NIDEK AFC-230. 45° FOV. 848x848: 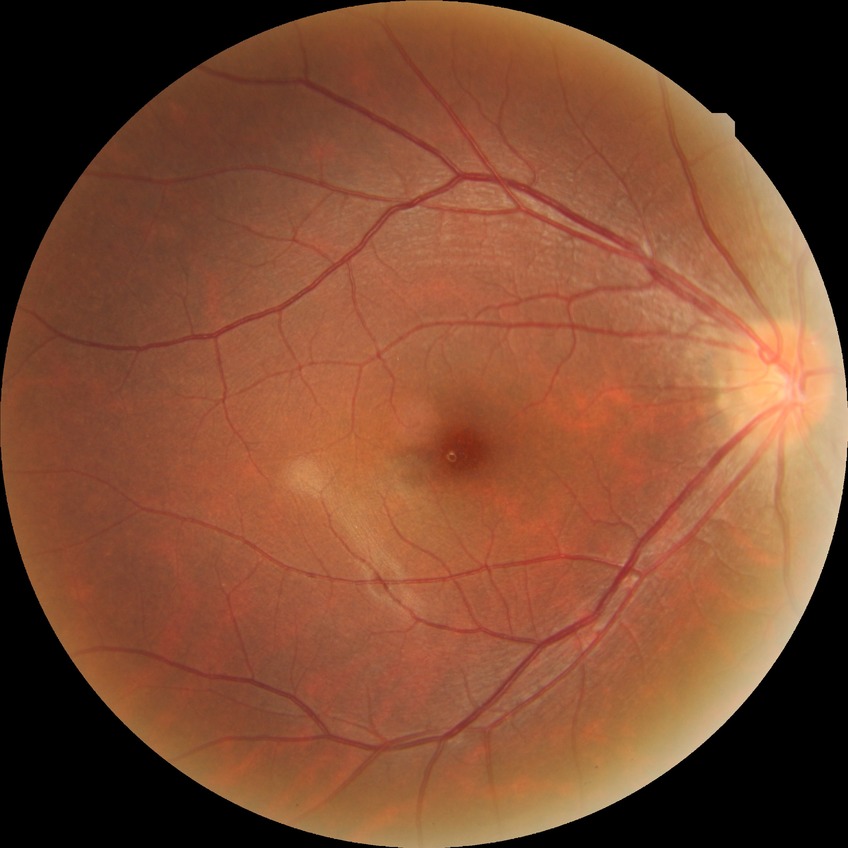 DR grade@NDR; DR impression@no apparent DR.